848 x 848 pixels · graded on the modified Davis scale · FOV: 45 degrees · posterior pole color fundus photograph.
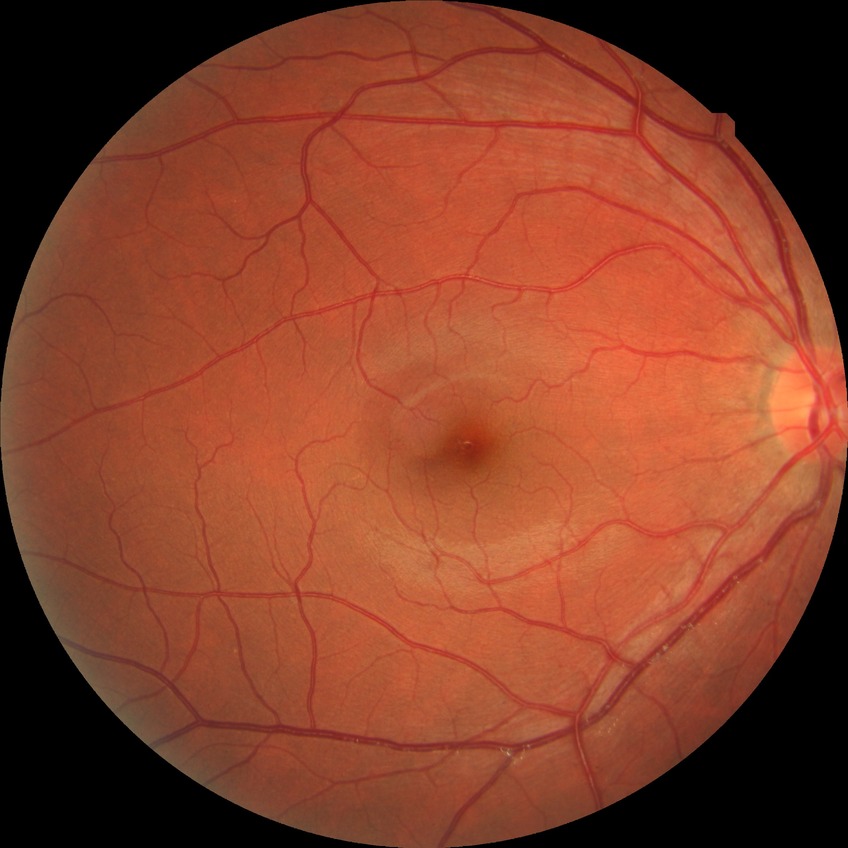 - diabetic retinopathy (DR): NDR (no diabetic retinopathy)